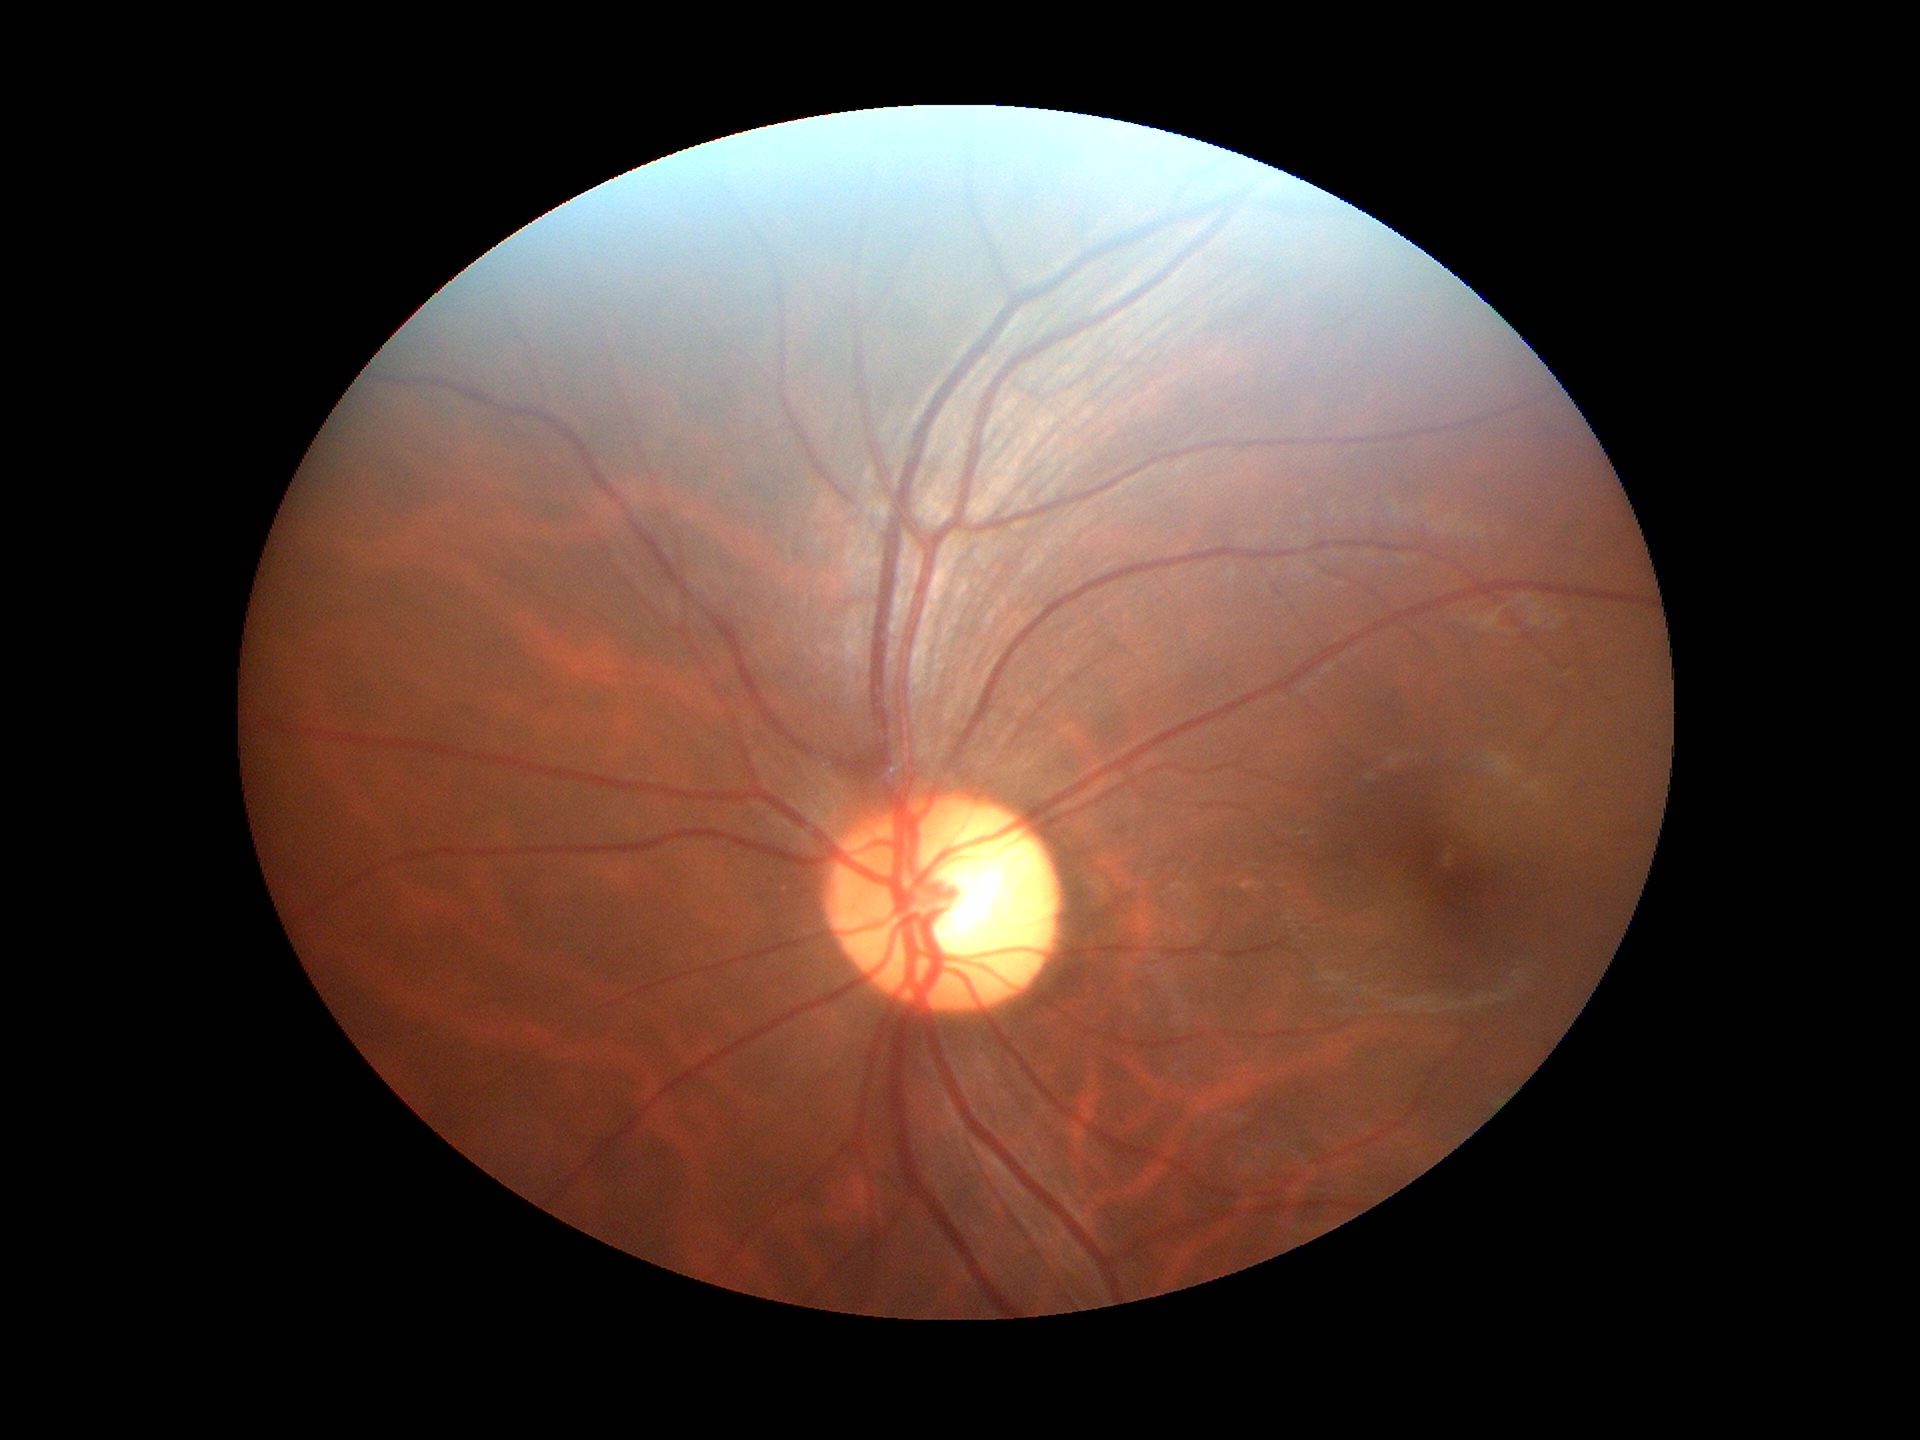
Glaucoma decision: no suspicious findings.
VCDR: 0.56.
HCDR is 0.57.